CFP.
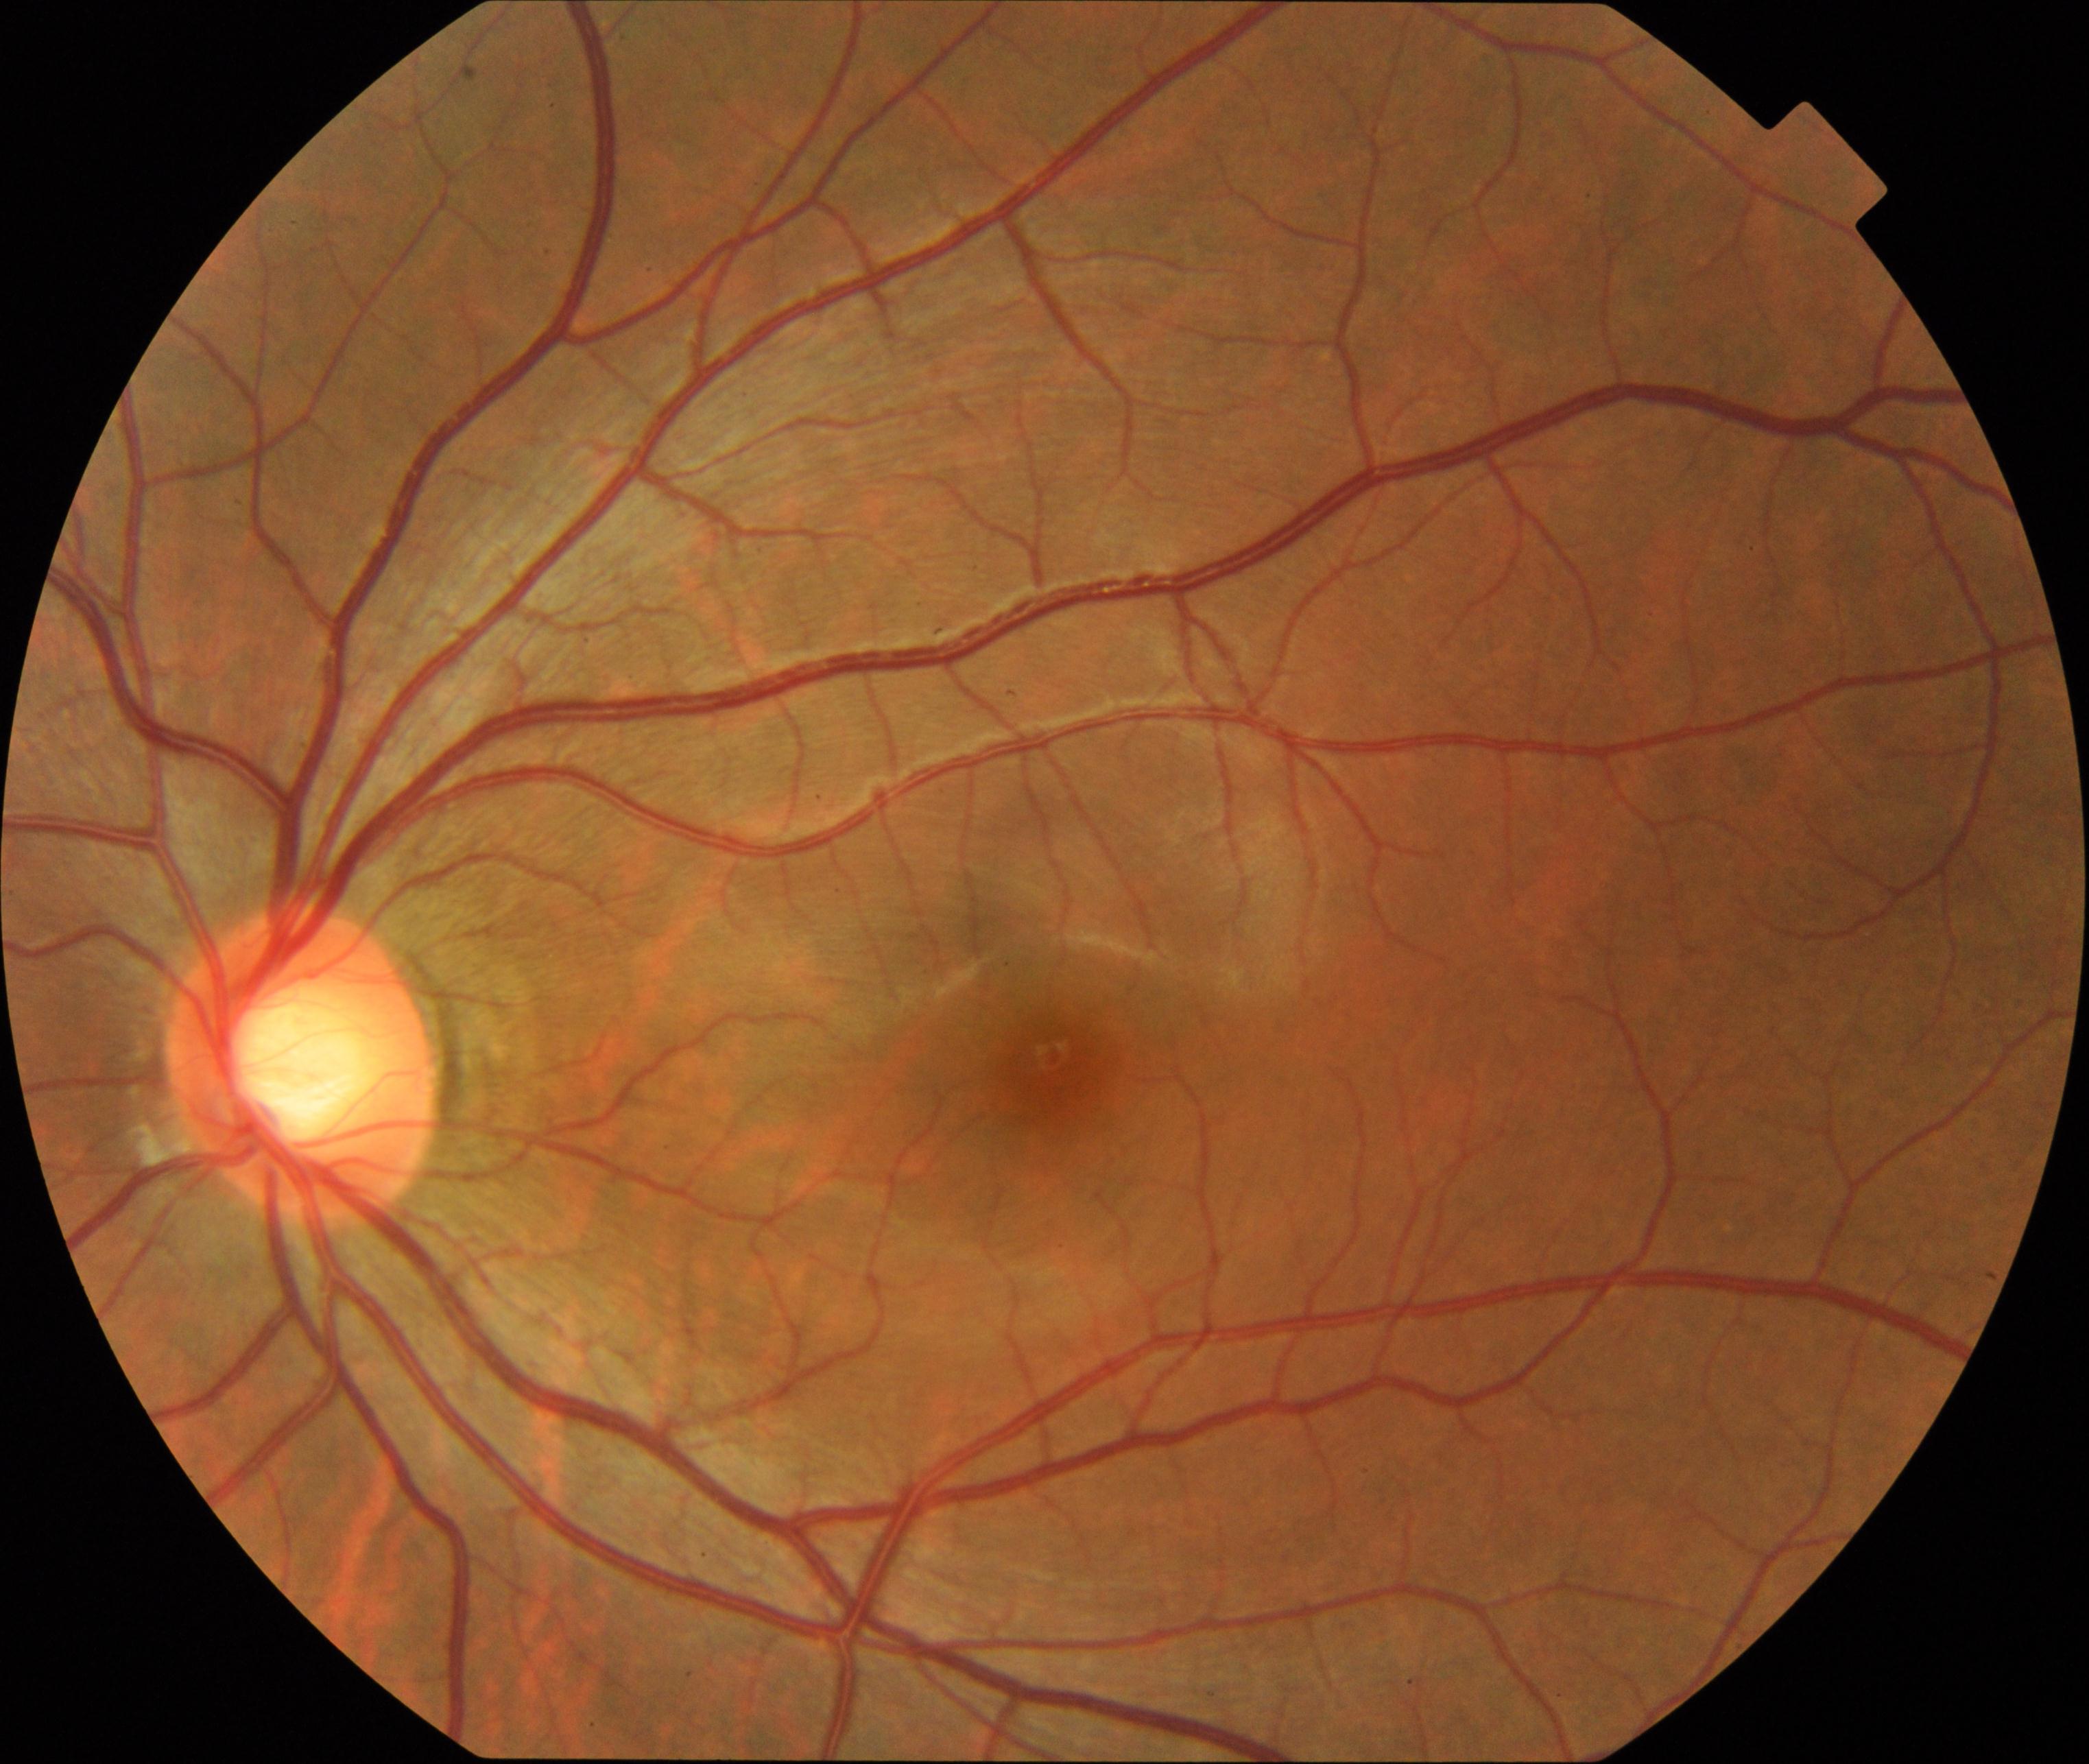 Impression: large optic cup.